Acquired with a NIDEK AFC-230. 45 degree fundus photograph. Retinal fundus photograph. Modified Davis grading:
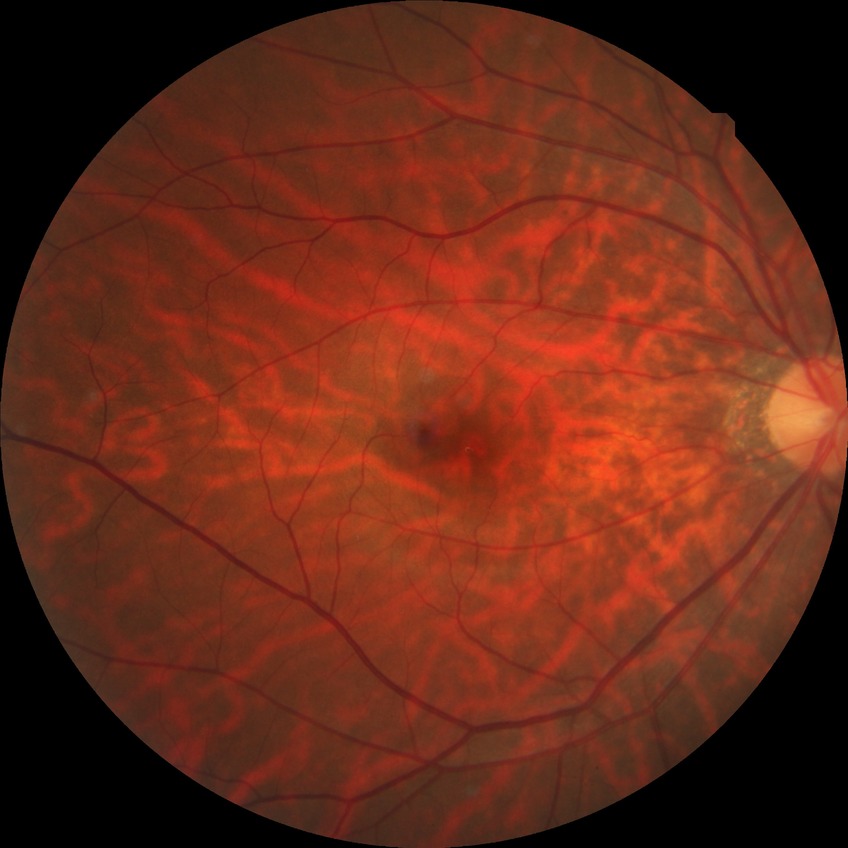

DR: NDR. No signs of diabetic retinopathy.